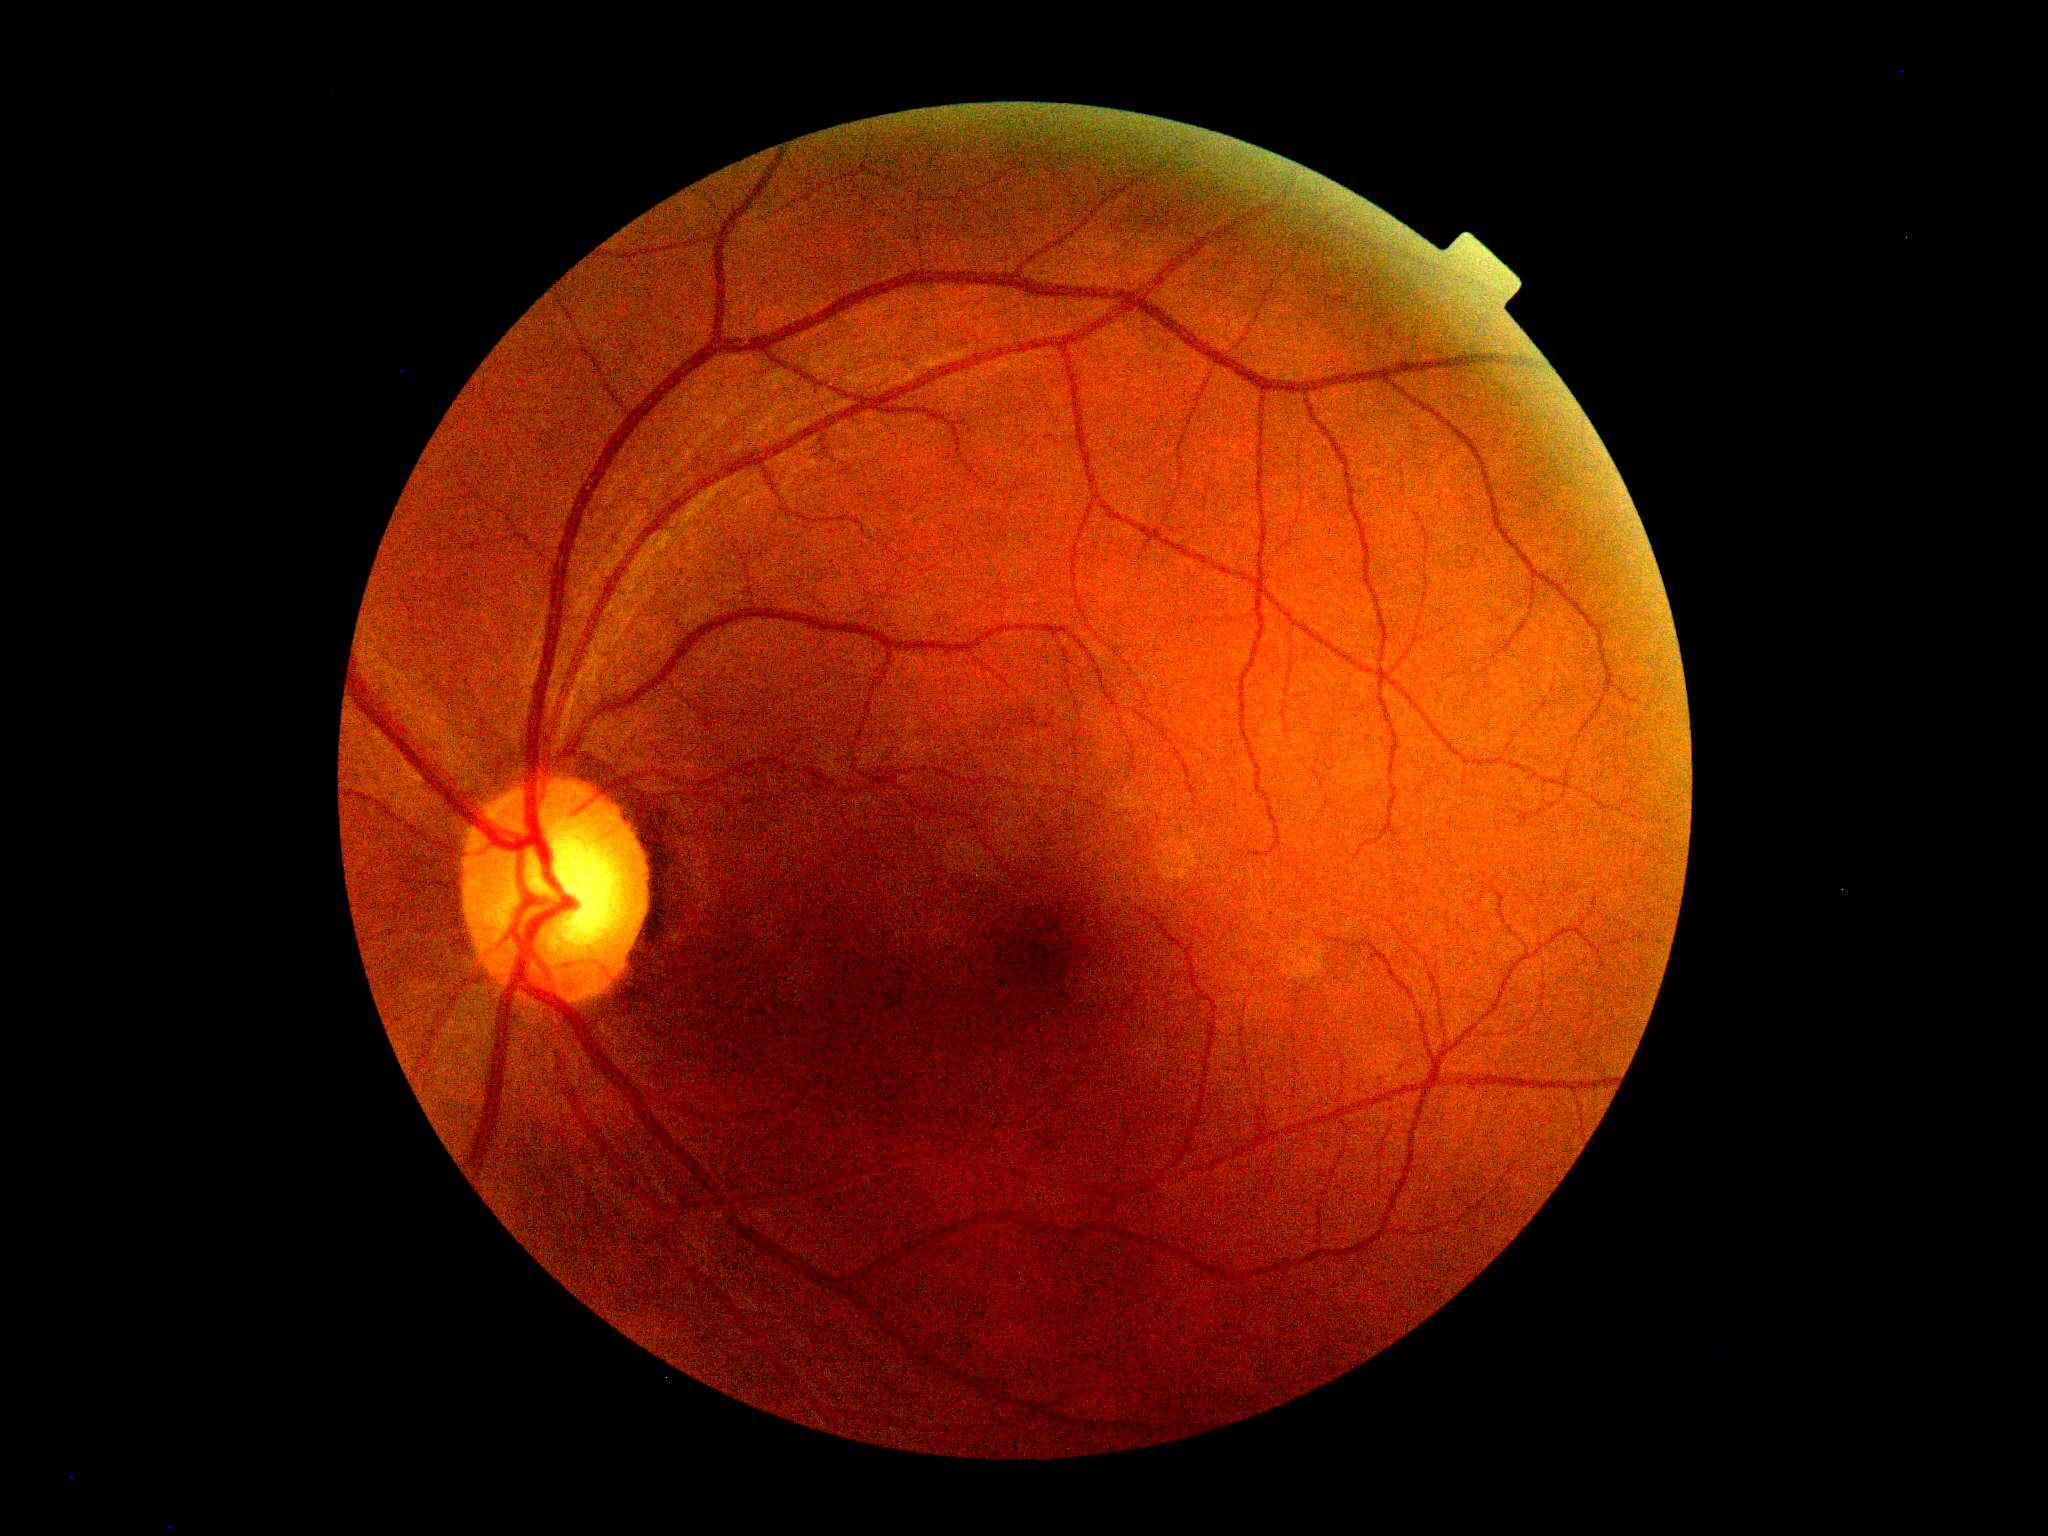
Diabetic retinopathy is grade 0.